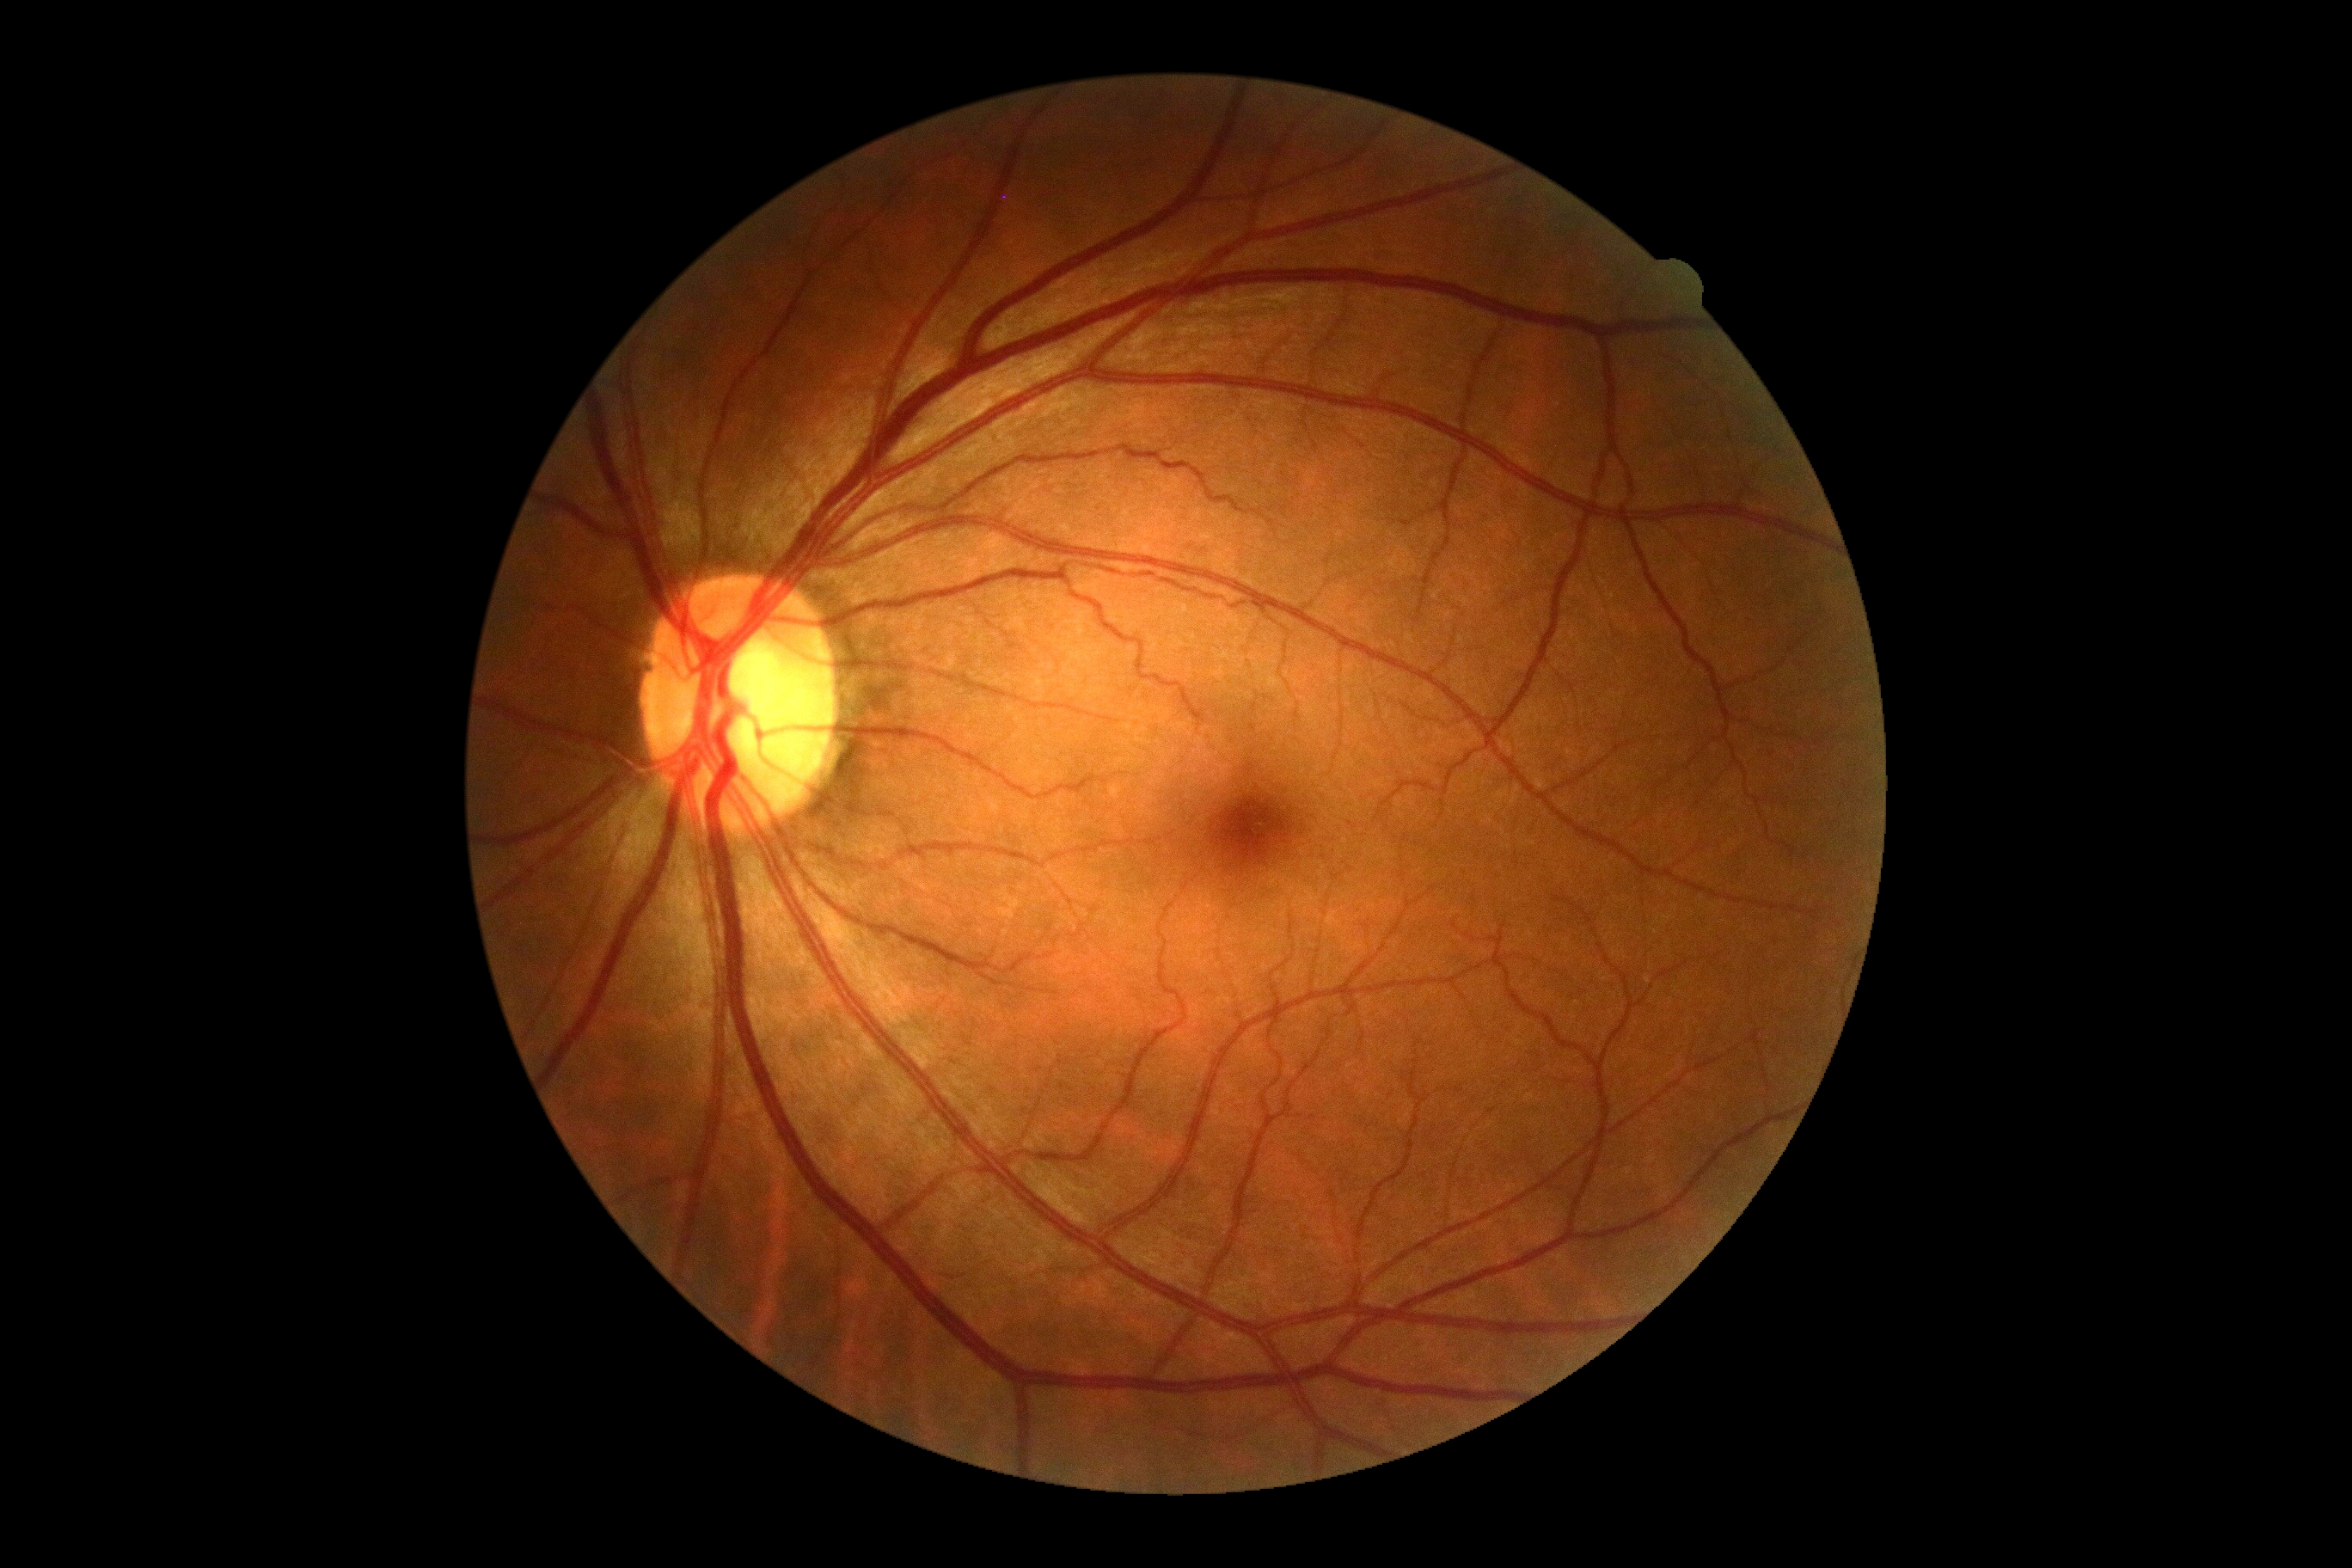
Findings:
– DR impression — no apparent DR
– diabetic retinopathy — grade 0